Wide-field fundus image from infant ROP screening. Image size 1240x1240.
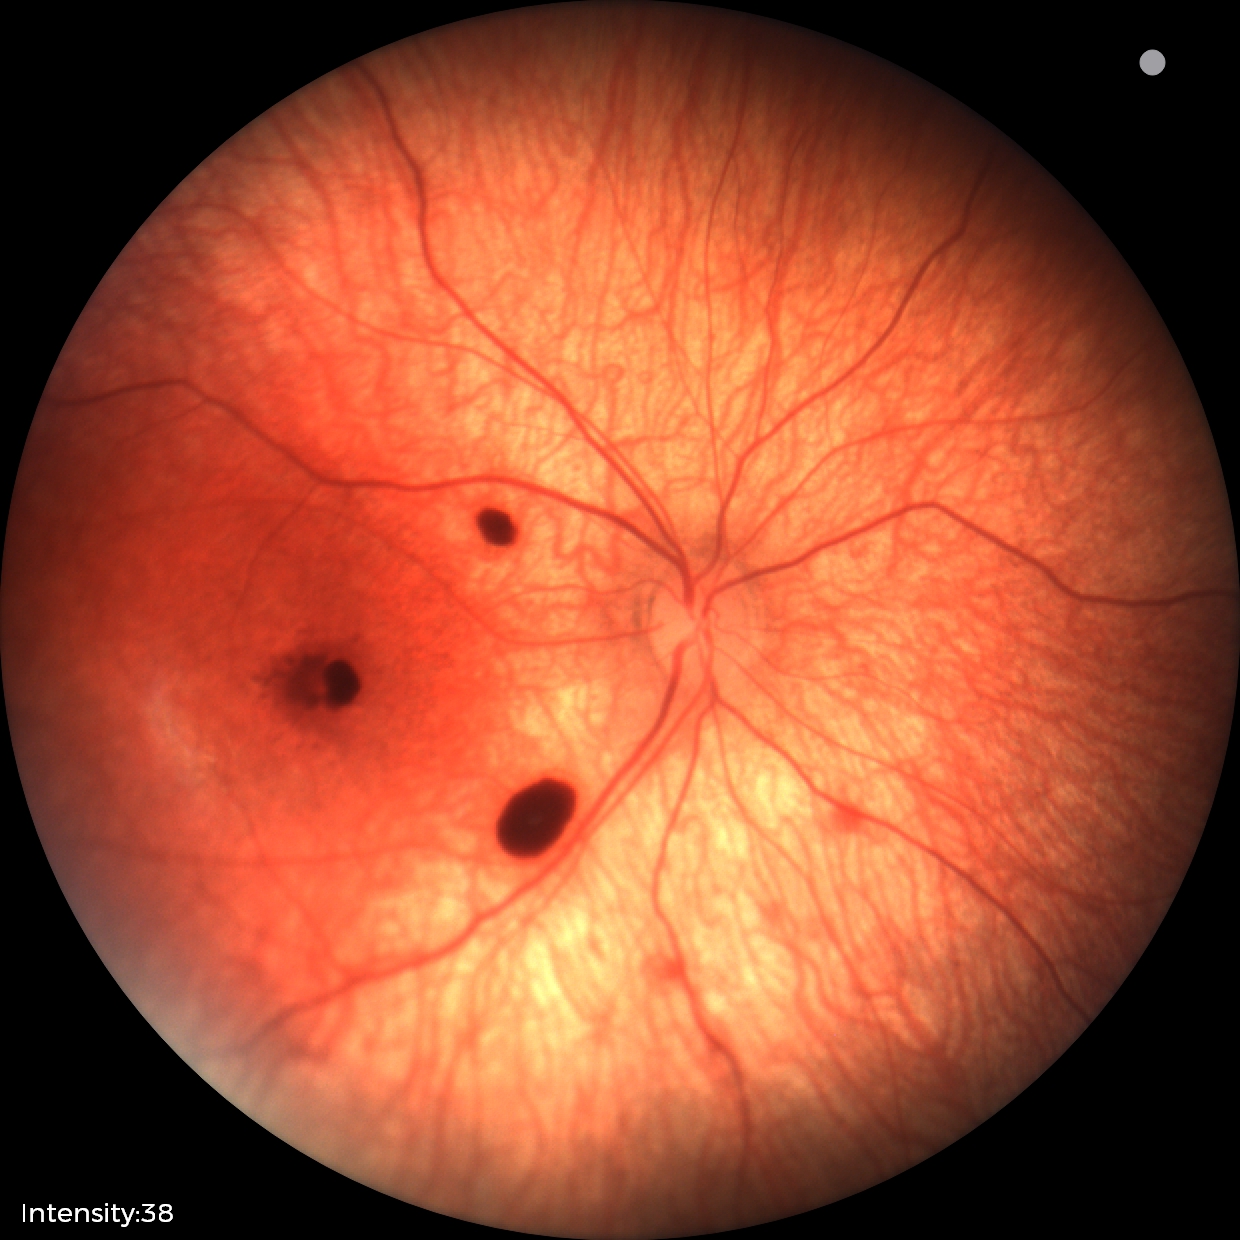 Diagnosis from this screening exam: retinal hemorrhages.